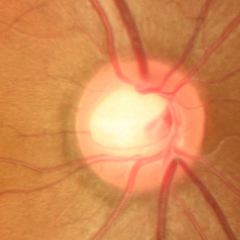
Q: What is the glaucoma diagnosis?
A: No — no evidence of glaucoma.